Image size 1659x2212, Remidio FOP fundus camera: 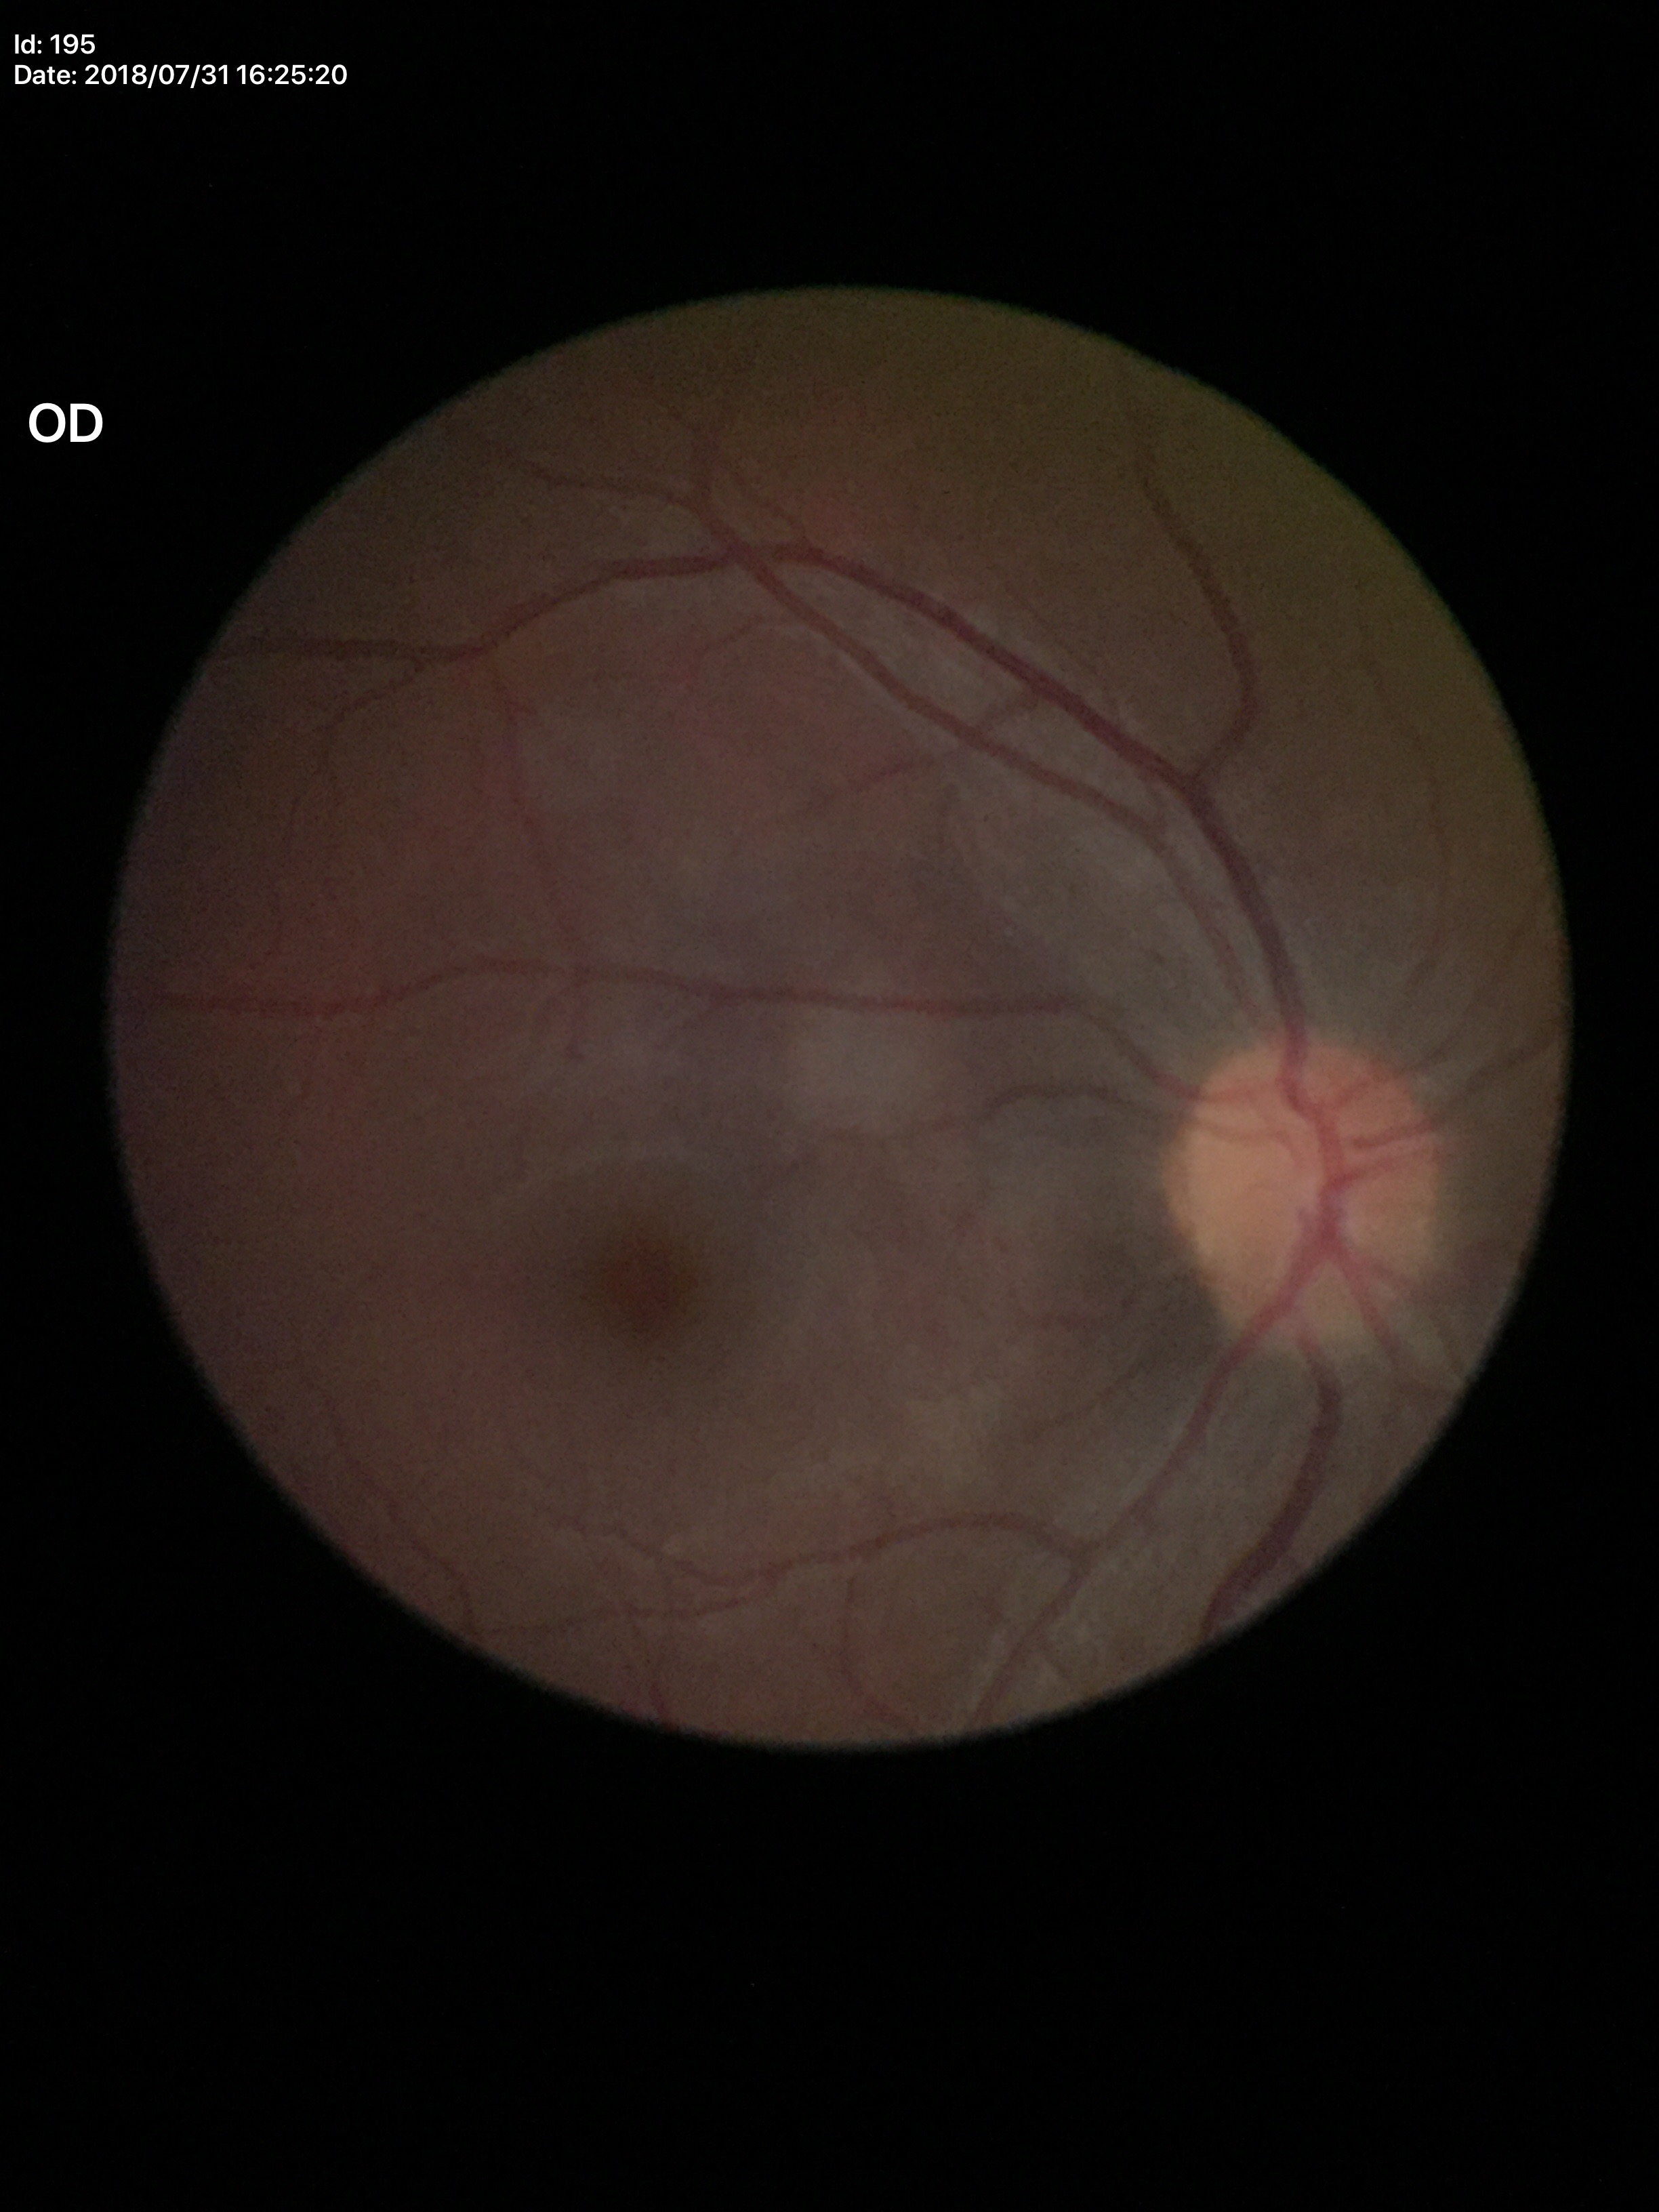

No glaucomatous findings. Vertical cup-to-disc ratio (VCDR) of 0.40.